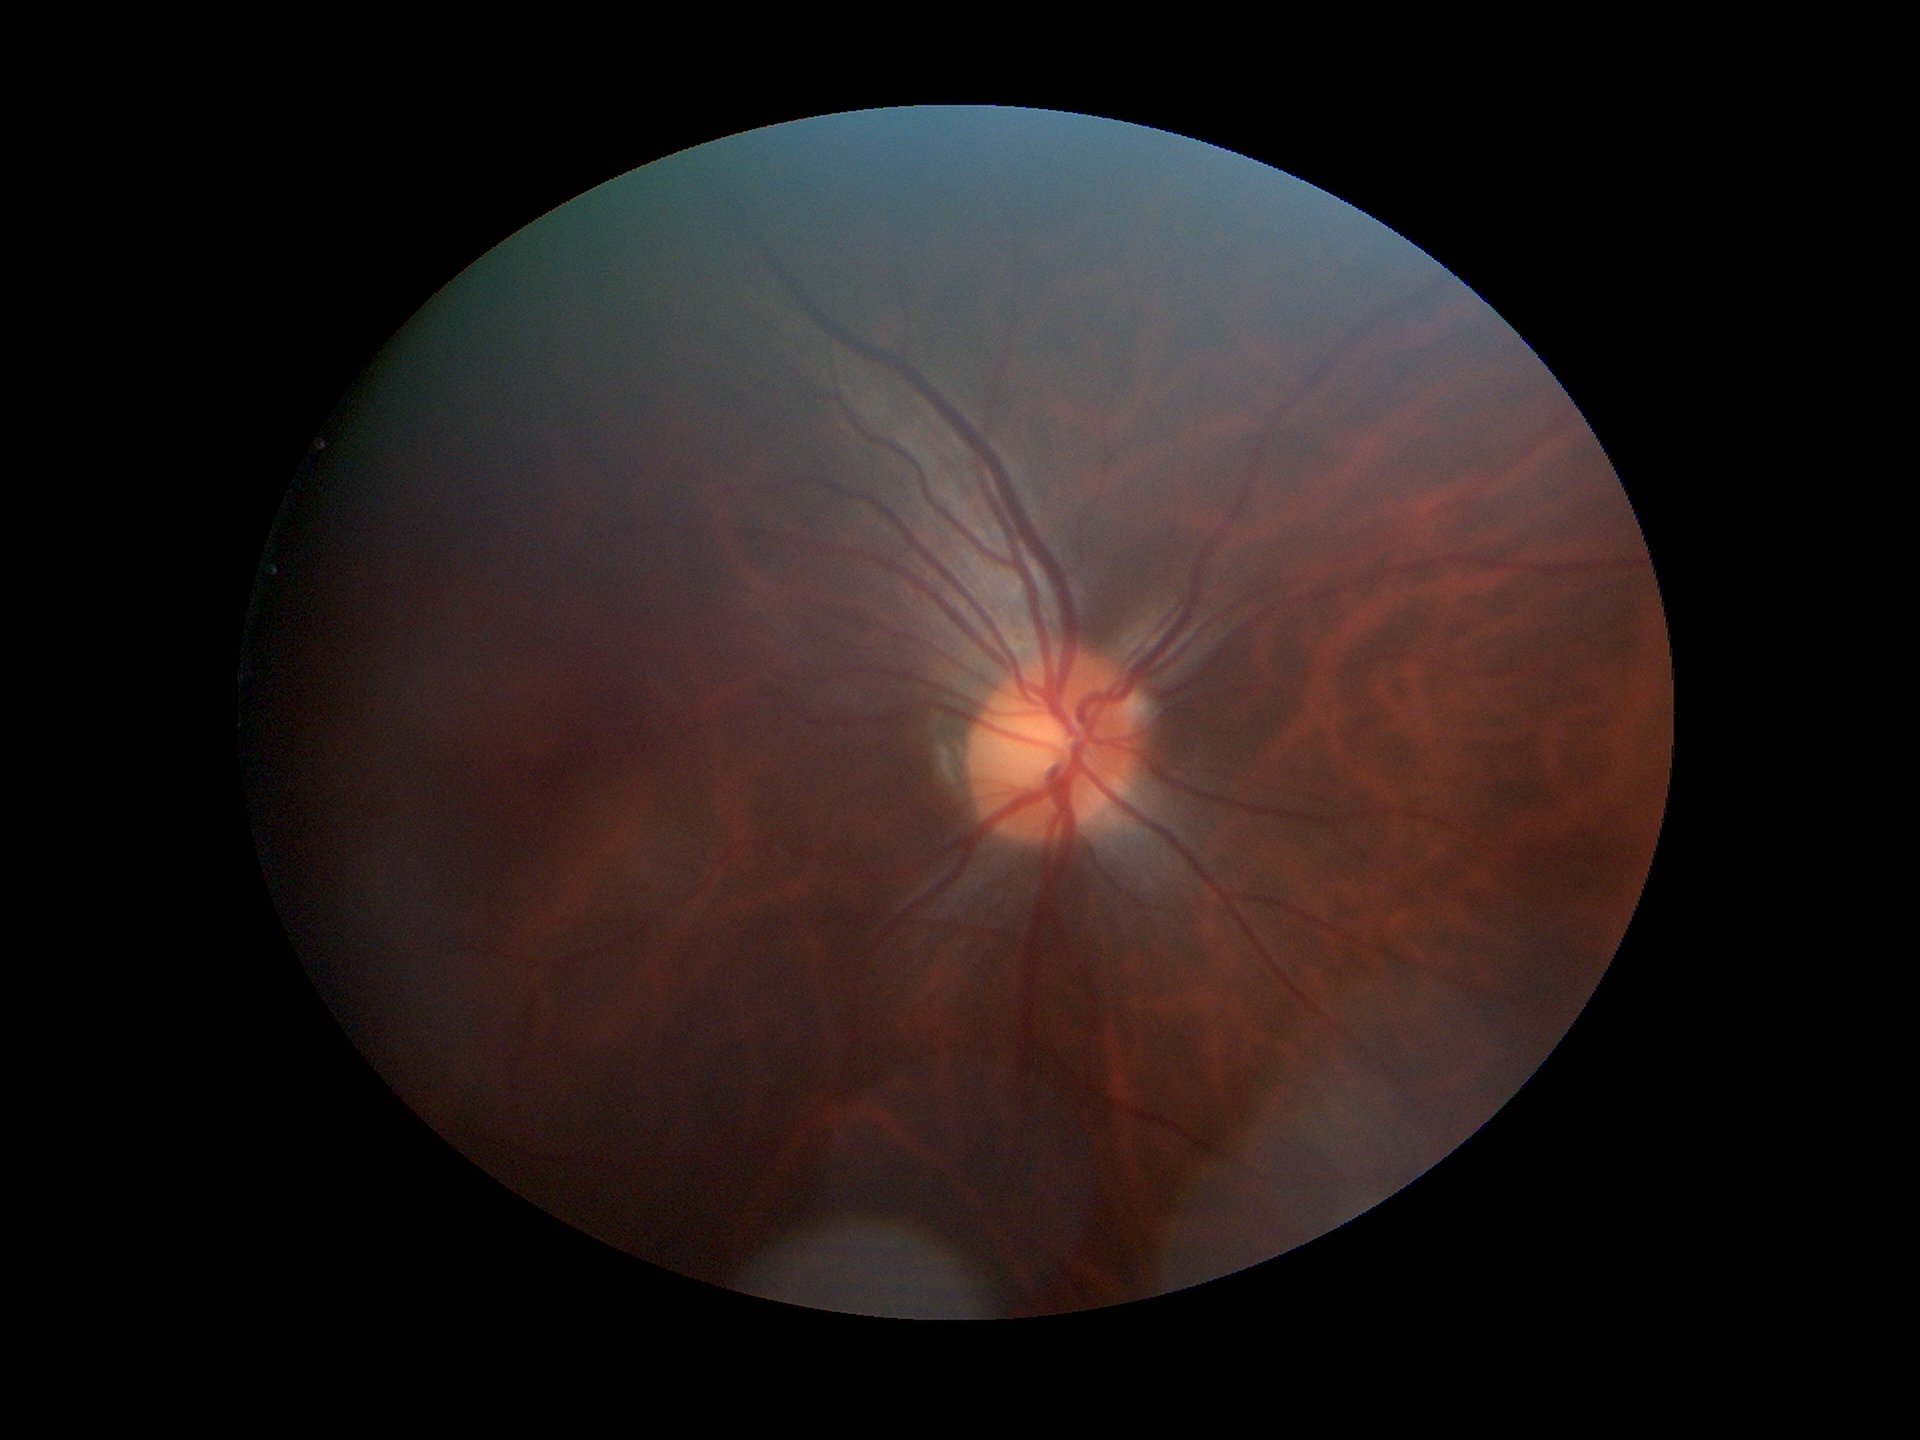
Optic disc analysis:
* horizontal cup-disc ratio · 0.47
* vertical cup-disc ratio · 0.46
* Glaucoma evaluation · not suspect